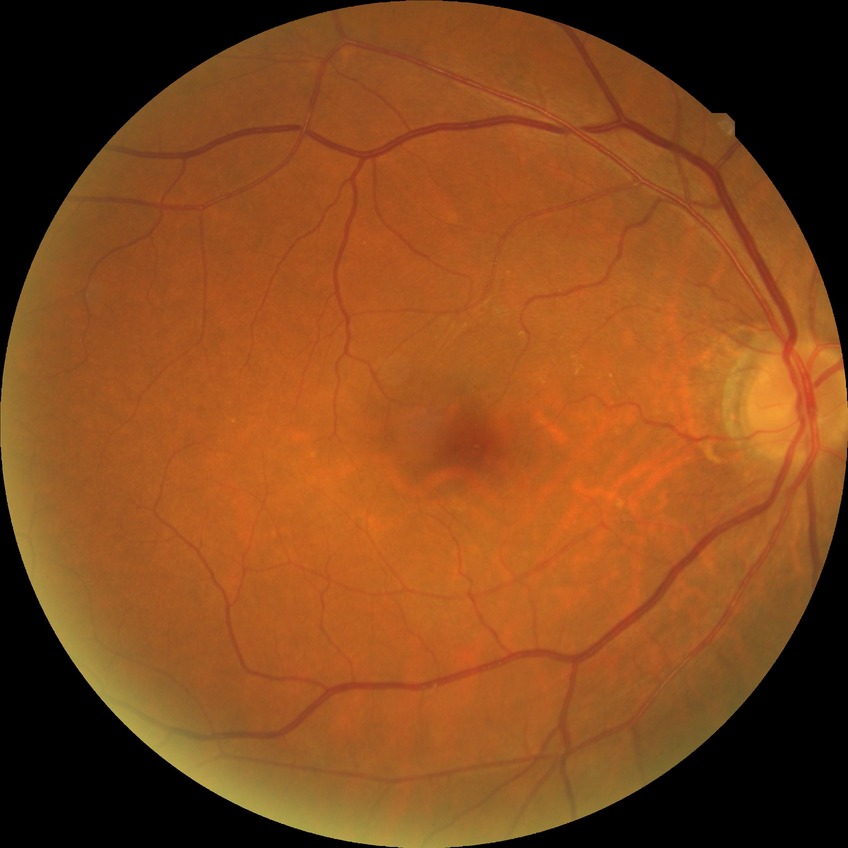

Modified Davis classification is no diabetic retinopathy.